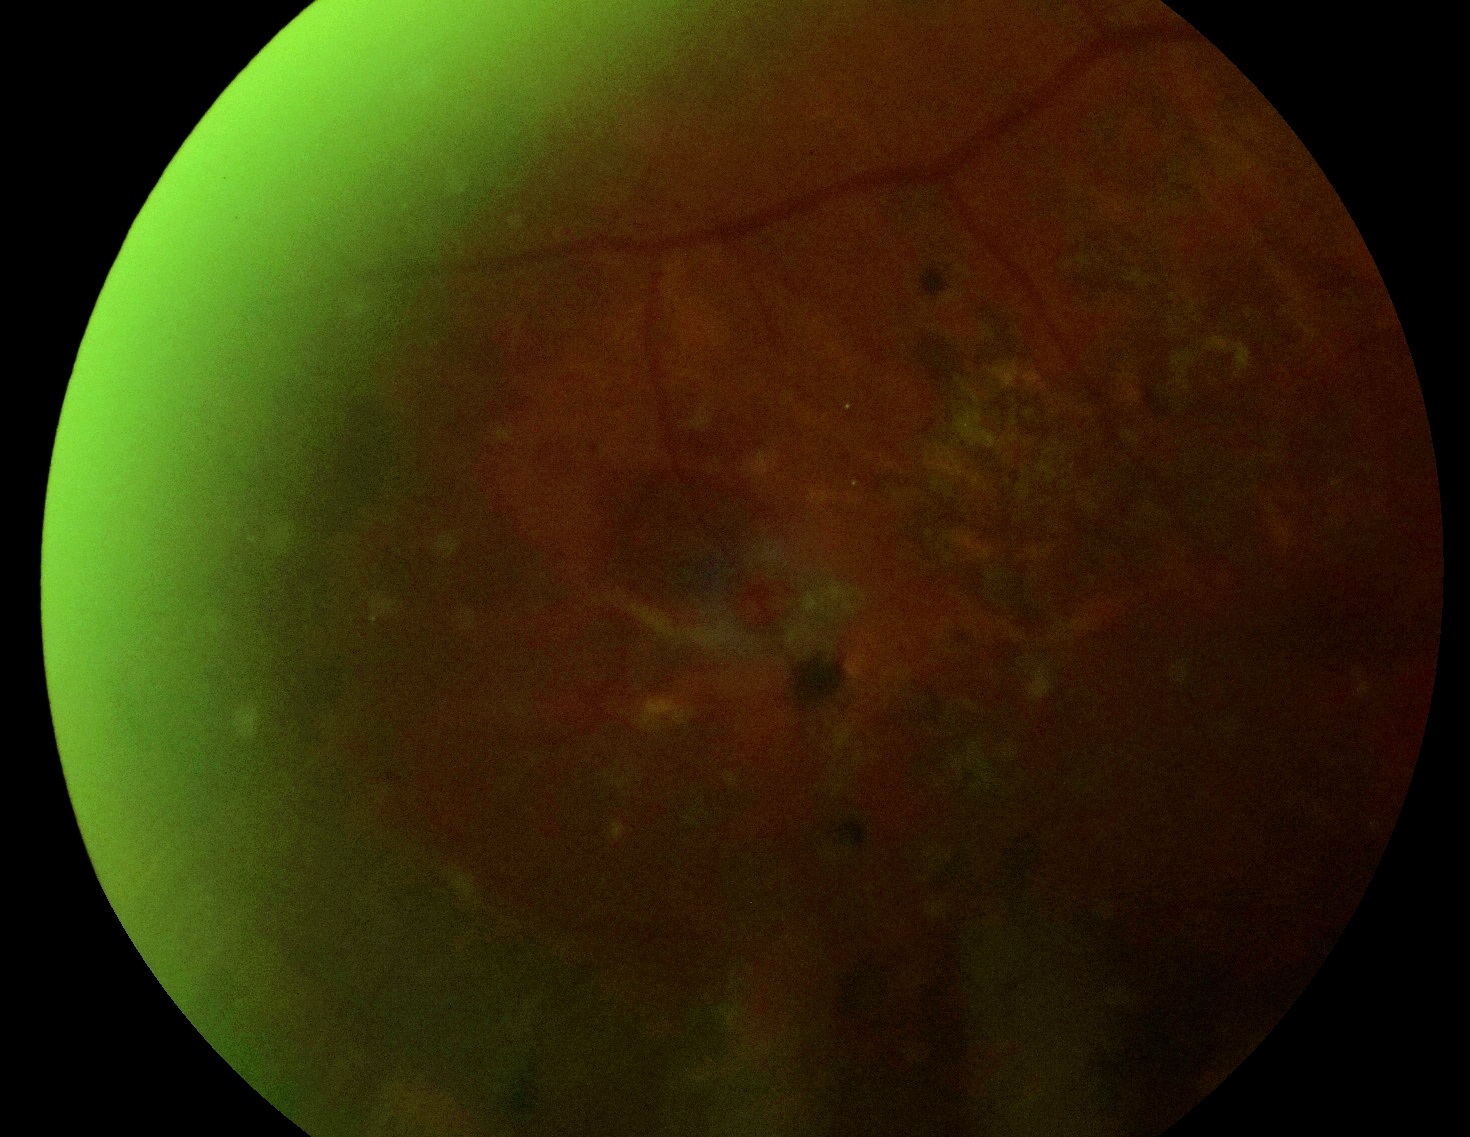 DR severity is ungradable due to poor image quality.